Wide-field fundus photograph of an infant
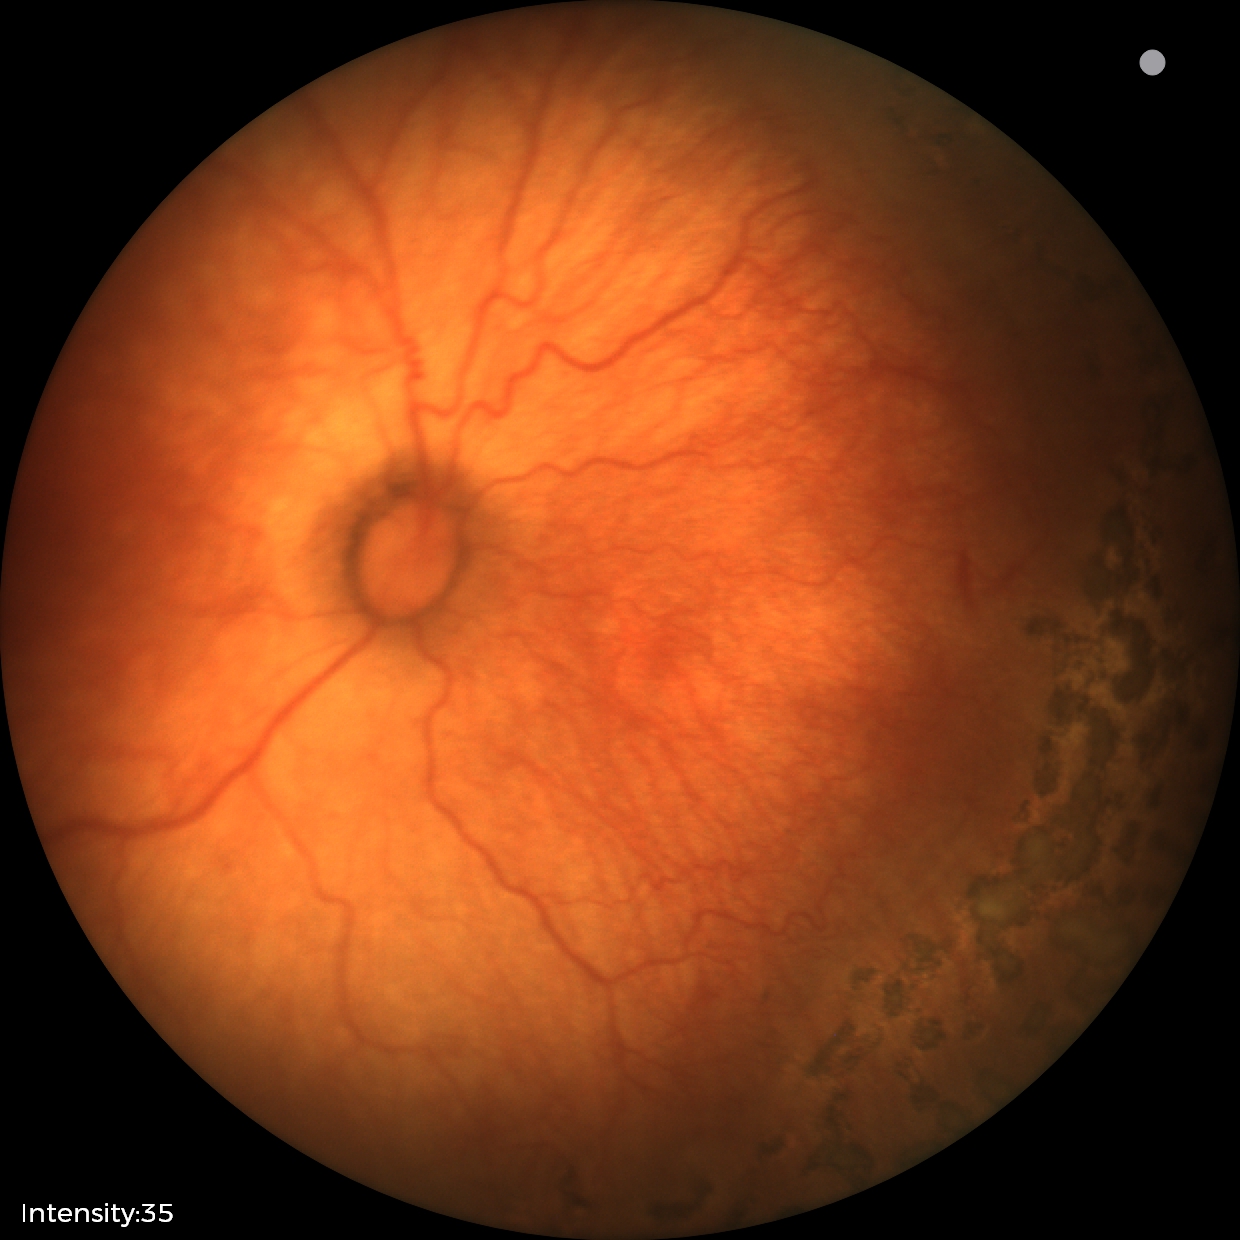 From an examination with diagnosis of ROP stage 1.